Retinal fundus photograph. 1920 by 1088 pixels:
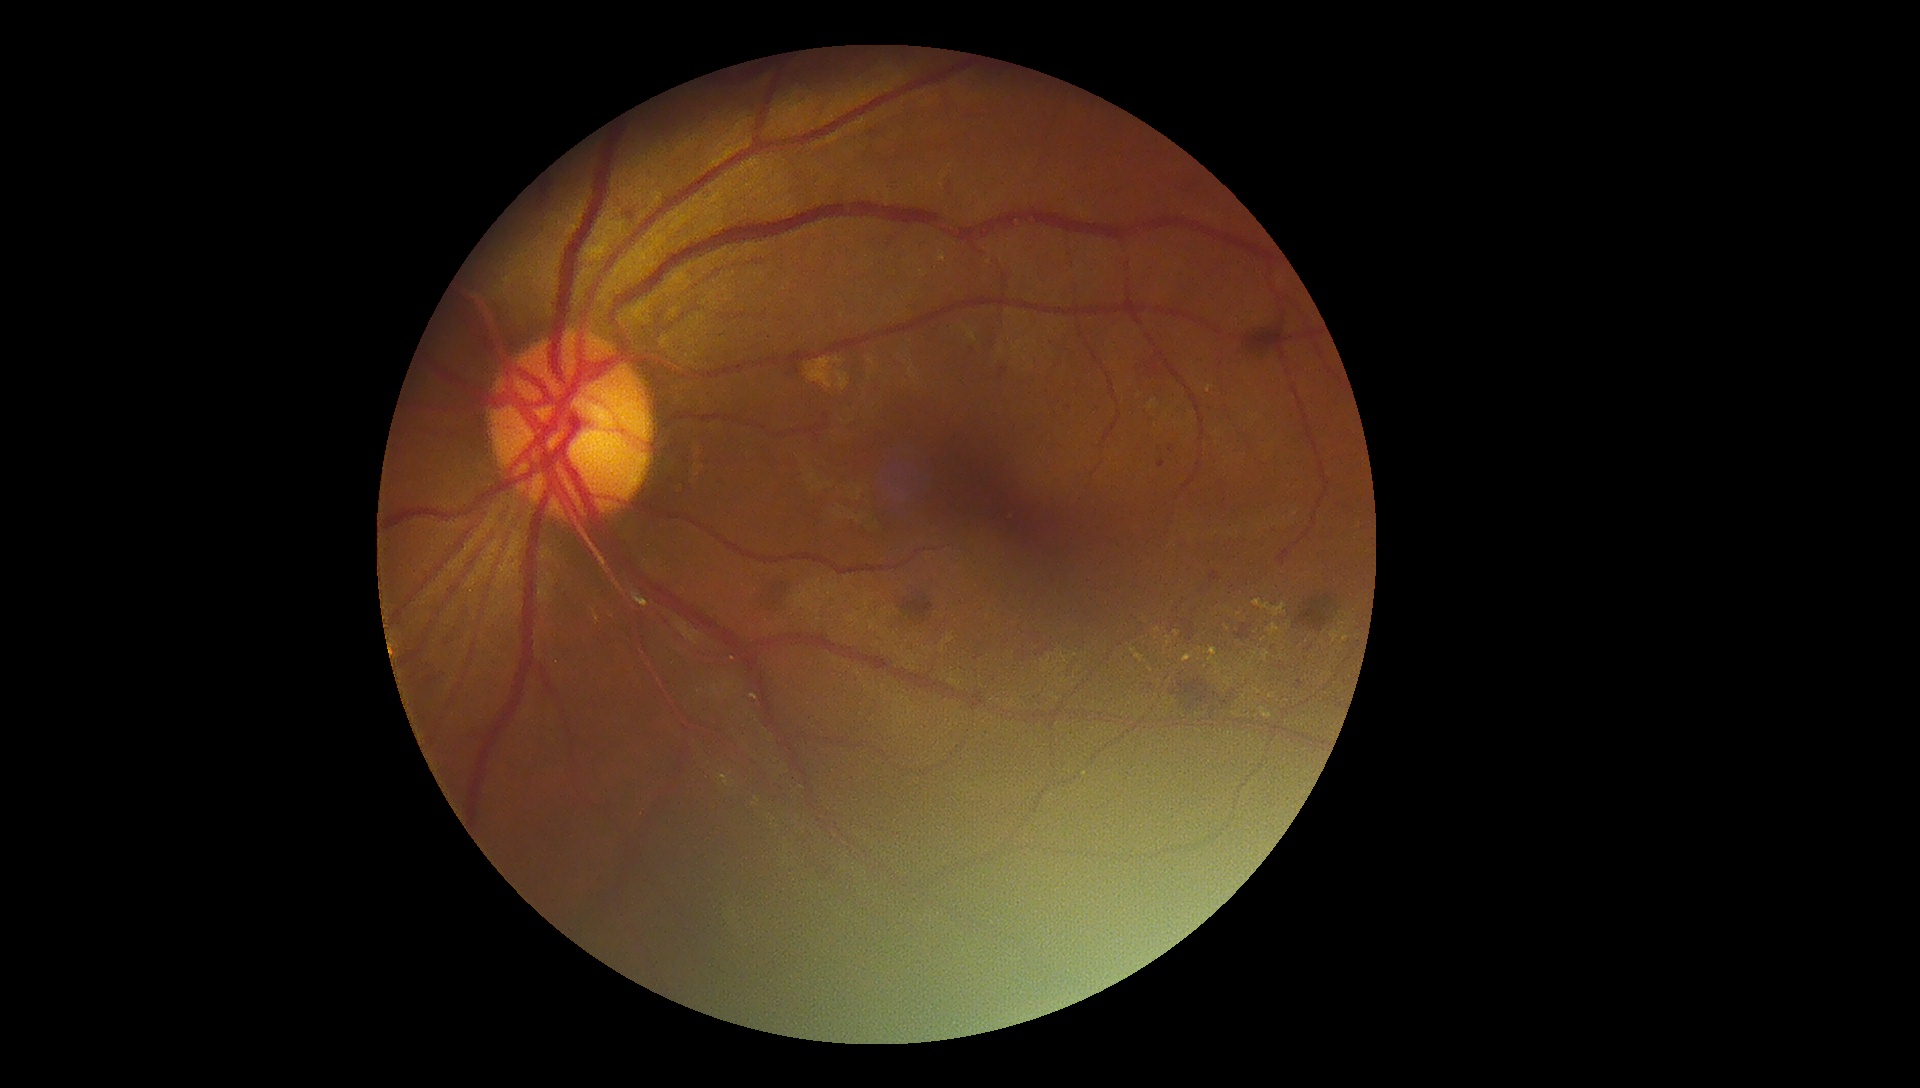
Retinopathy is 2/4
A subset of detected lesions:
• hard exudates (continued): x1=1329, y1=627, x2=1345, y2=646; x1=1183, y1=652, x2=1194, y2=663; x1=1253, y1=687, x2=1261, y2=694; x1=1216, y1=669, x2=1223, y2=678; x1=719, y1=774, x2=730, y2=787; x1=1253, y1=599, x2=1287, y2=617; x1=1132, y1=649, x2=1145, y2=663; x1=1262, y1=650, x2=1270, y2=662
• Small hard exudates approximately at [x=1160, y=681]; [x=1244, y=698]; [x=1342, y=624]; [x=1322, y=643]; [x=1177, y=634]; [x=1205, y=667]; [x=1227, y=628]; [x=1229, y=680]; [x=1255, y=654]; [x=1157, y=630]; [x=1239, y=615]